45-degree field of view, CFP, 1932 by 1932 pixels.
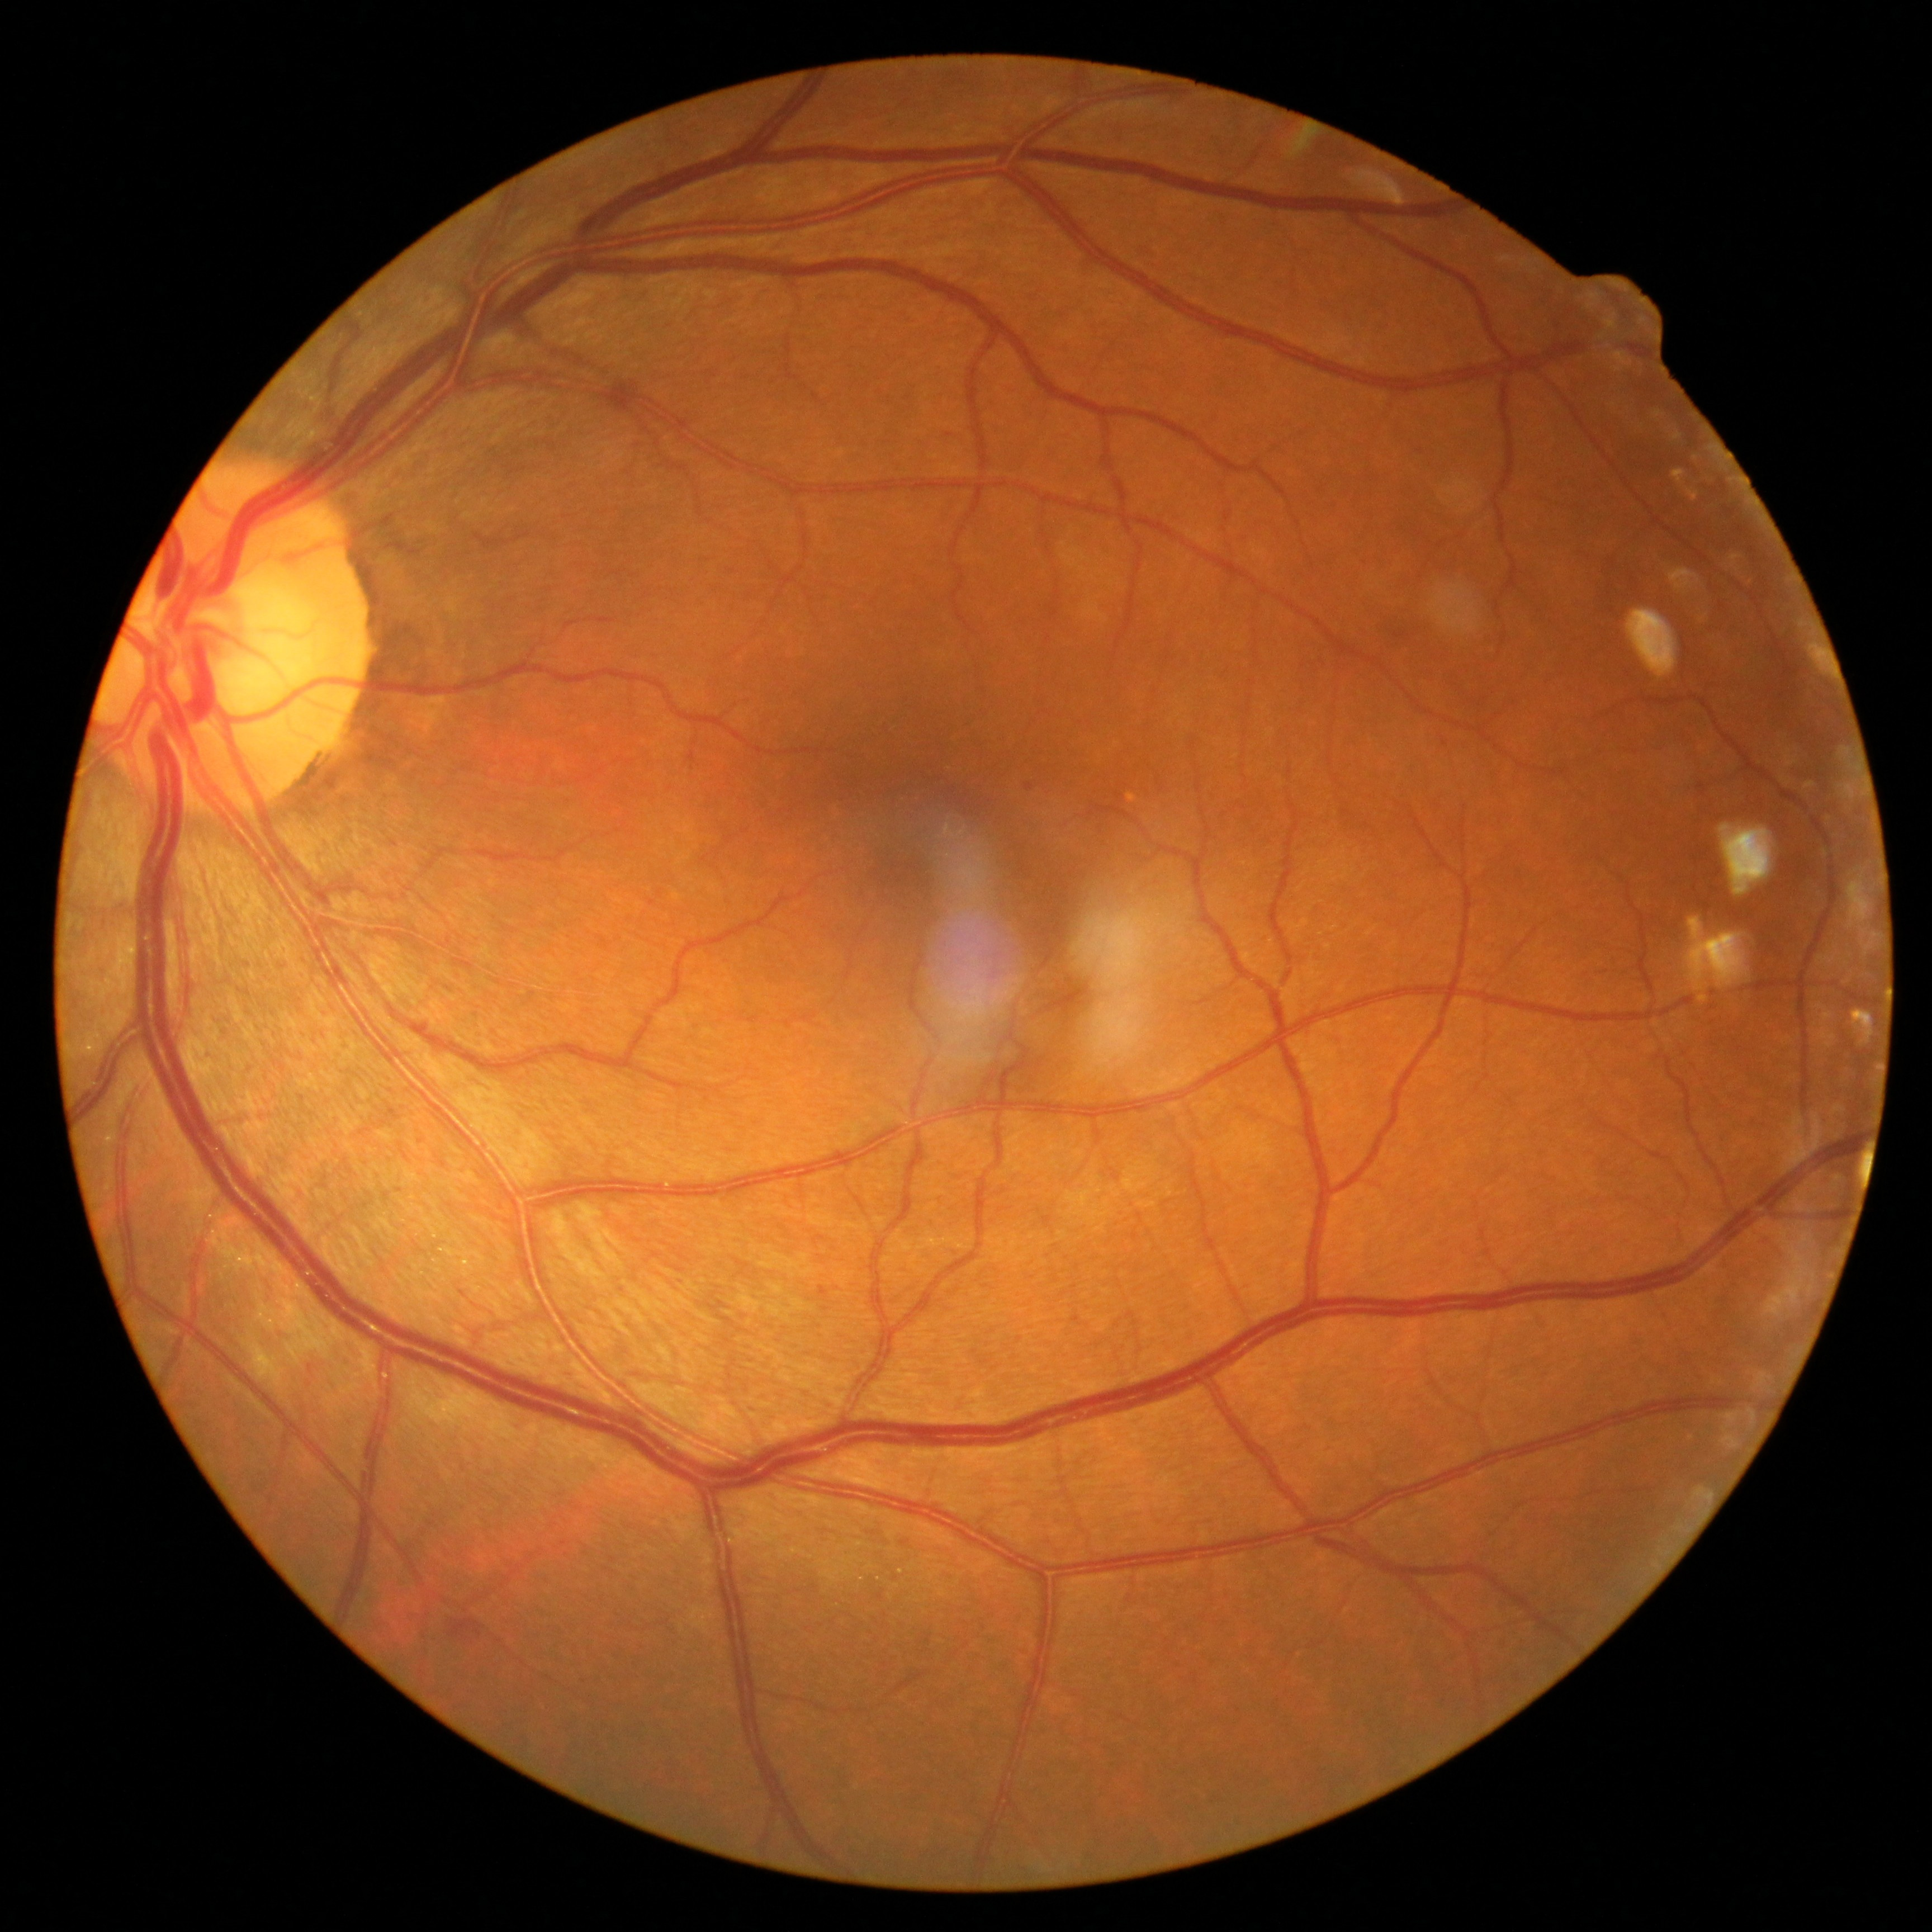 DR severity@grade 2 (moderate NPDR).